Color fundus image; captured on a Bosch fundus camera; 1920x1440px — 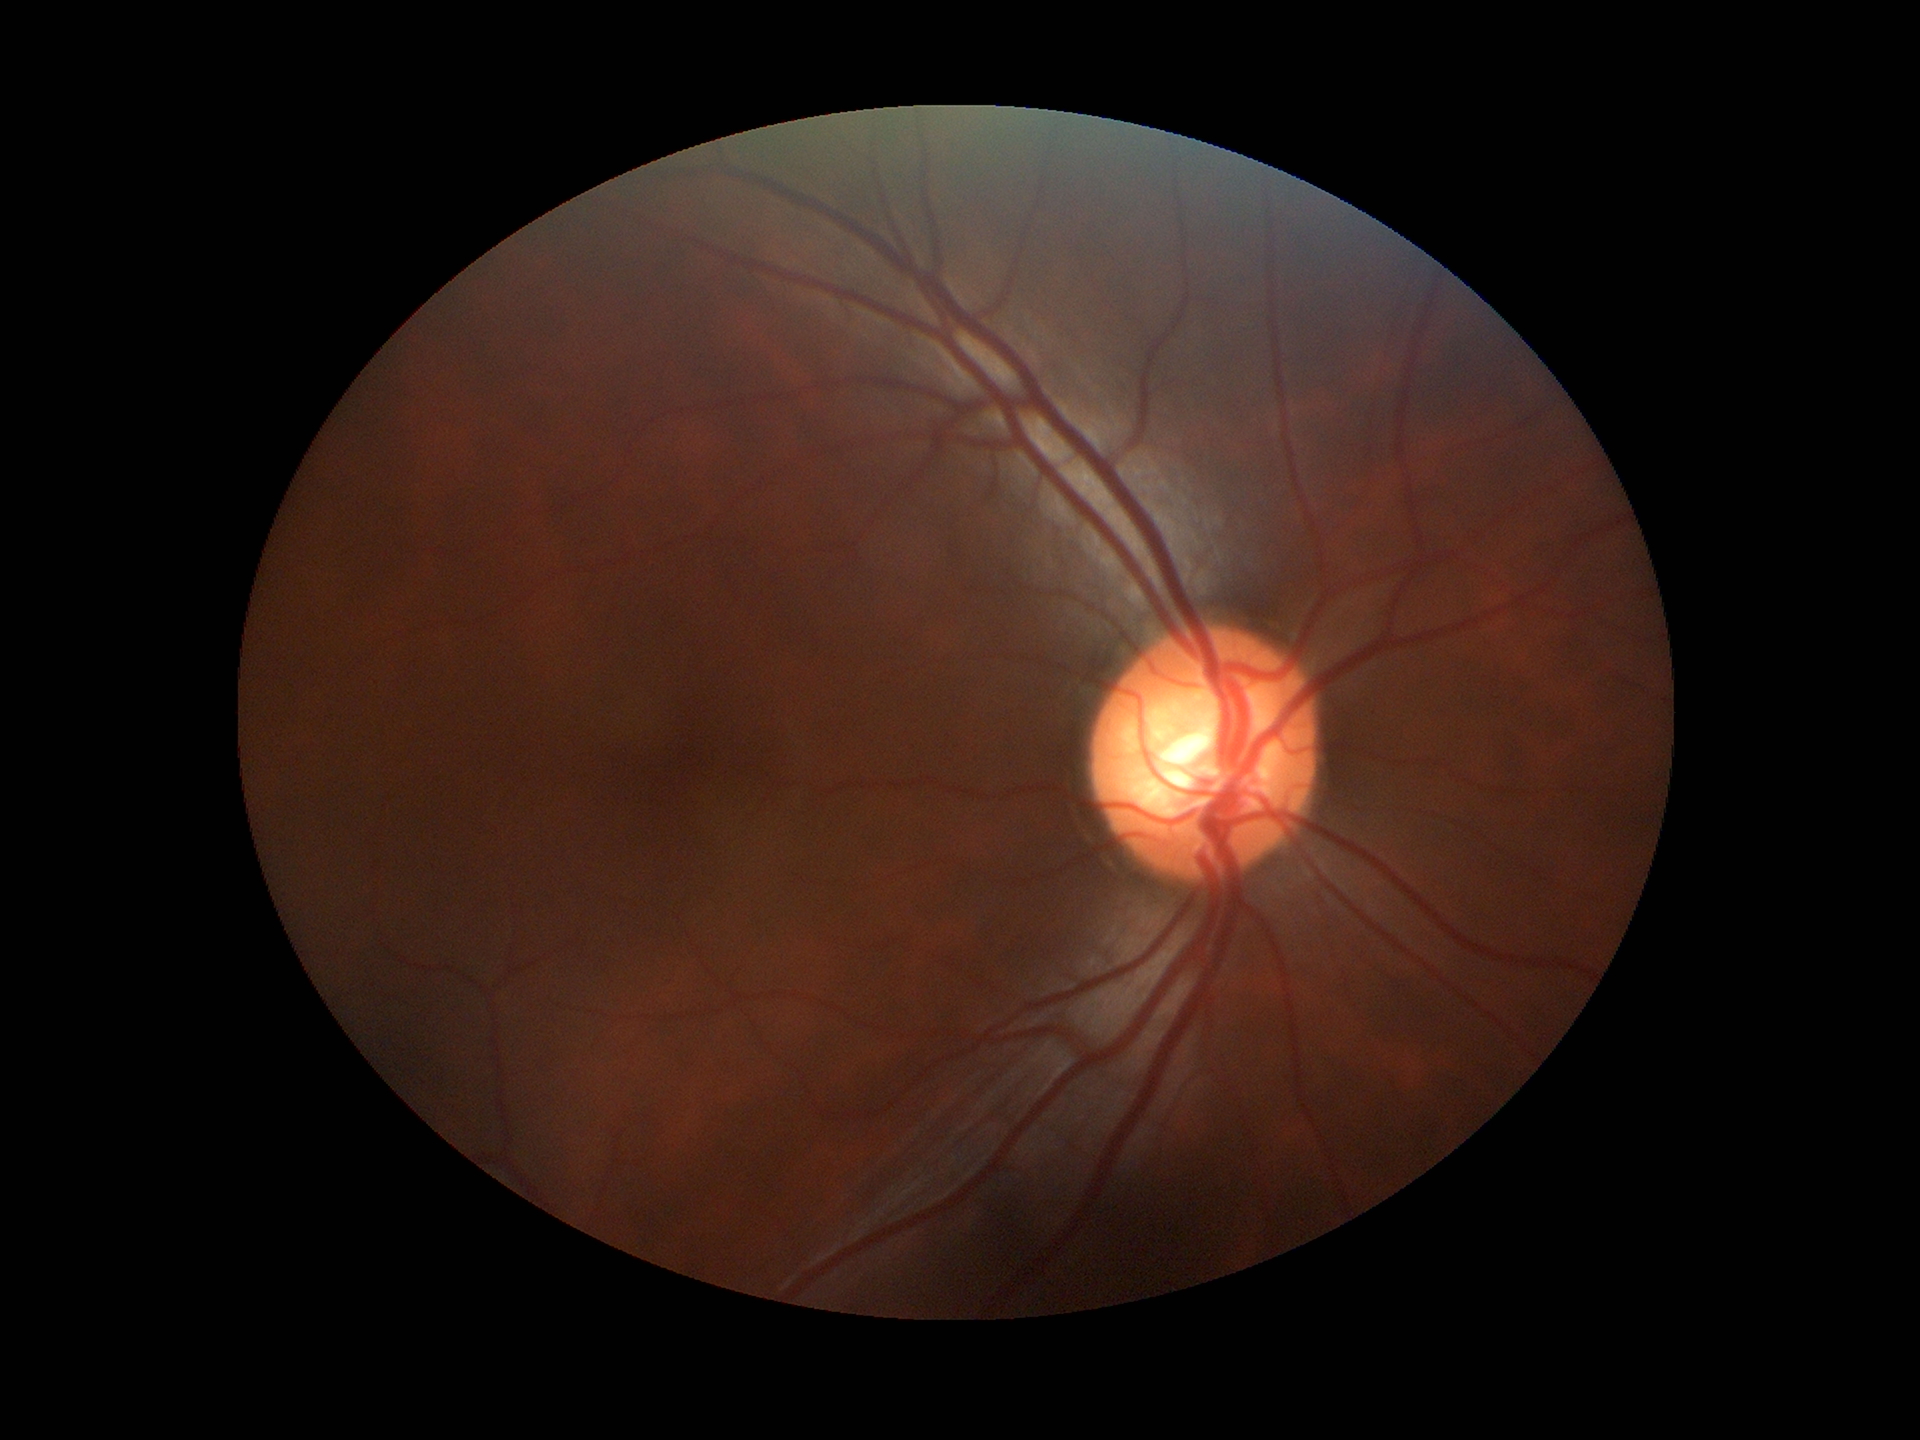
Glaucoma evaluation: suspicious findings.
Vertical C/D ratio is 0.64.